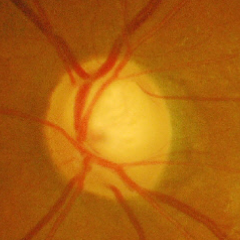 Glaucoma assessment: advanced glaucoma. Defined as near-total cupping of the optic nerve head, with or without severe visual field loss within the central 10 degrees of fixation.